Color fundus photograph. 45-degree field of view — 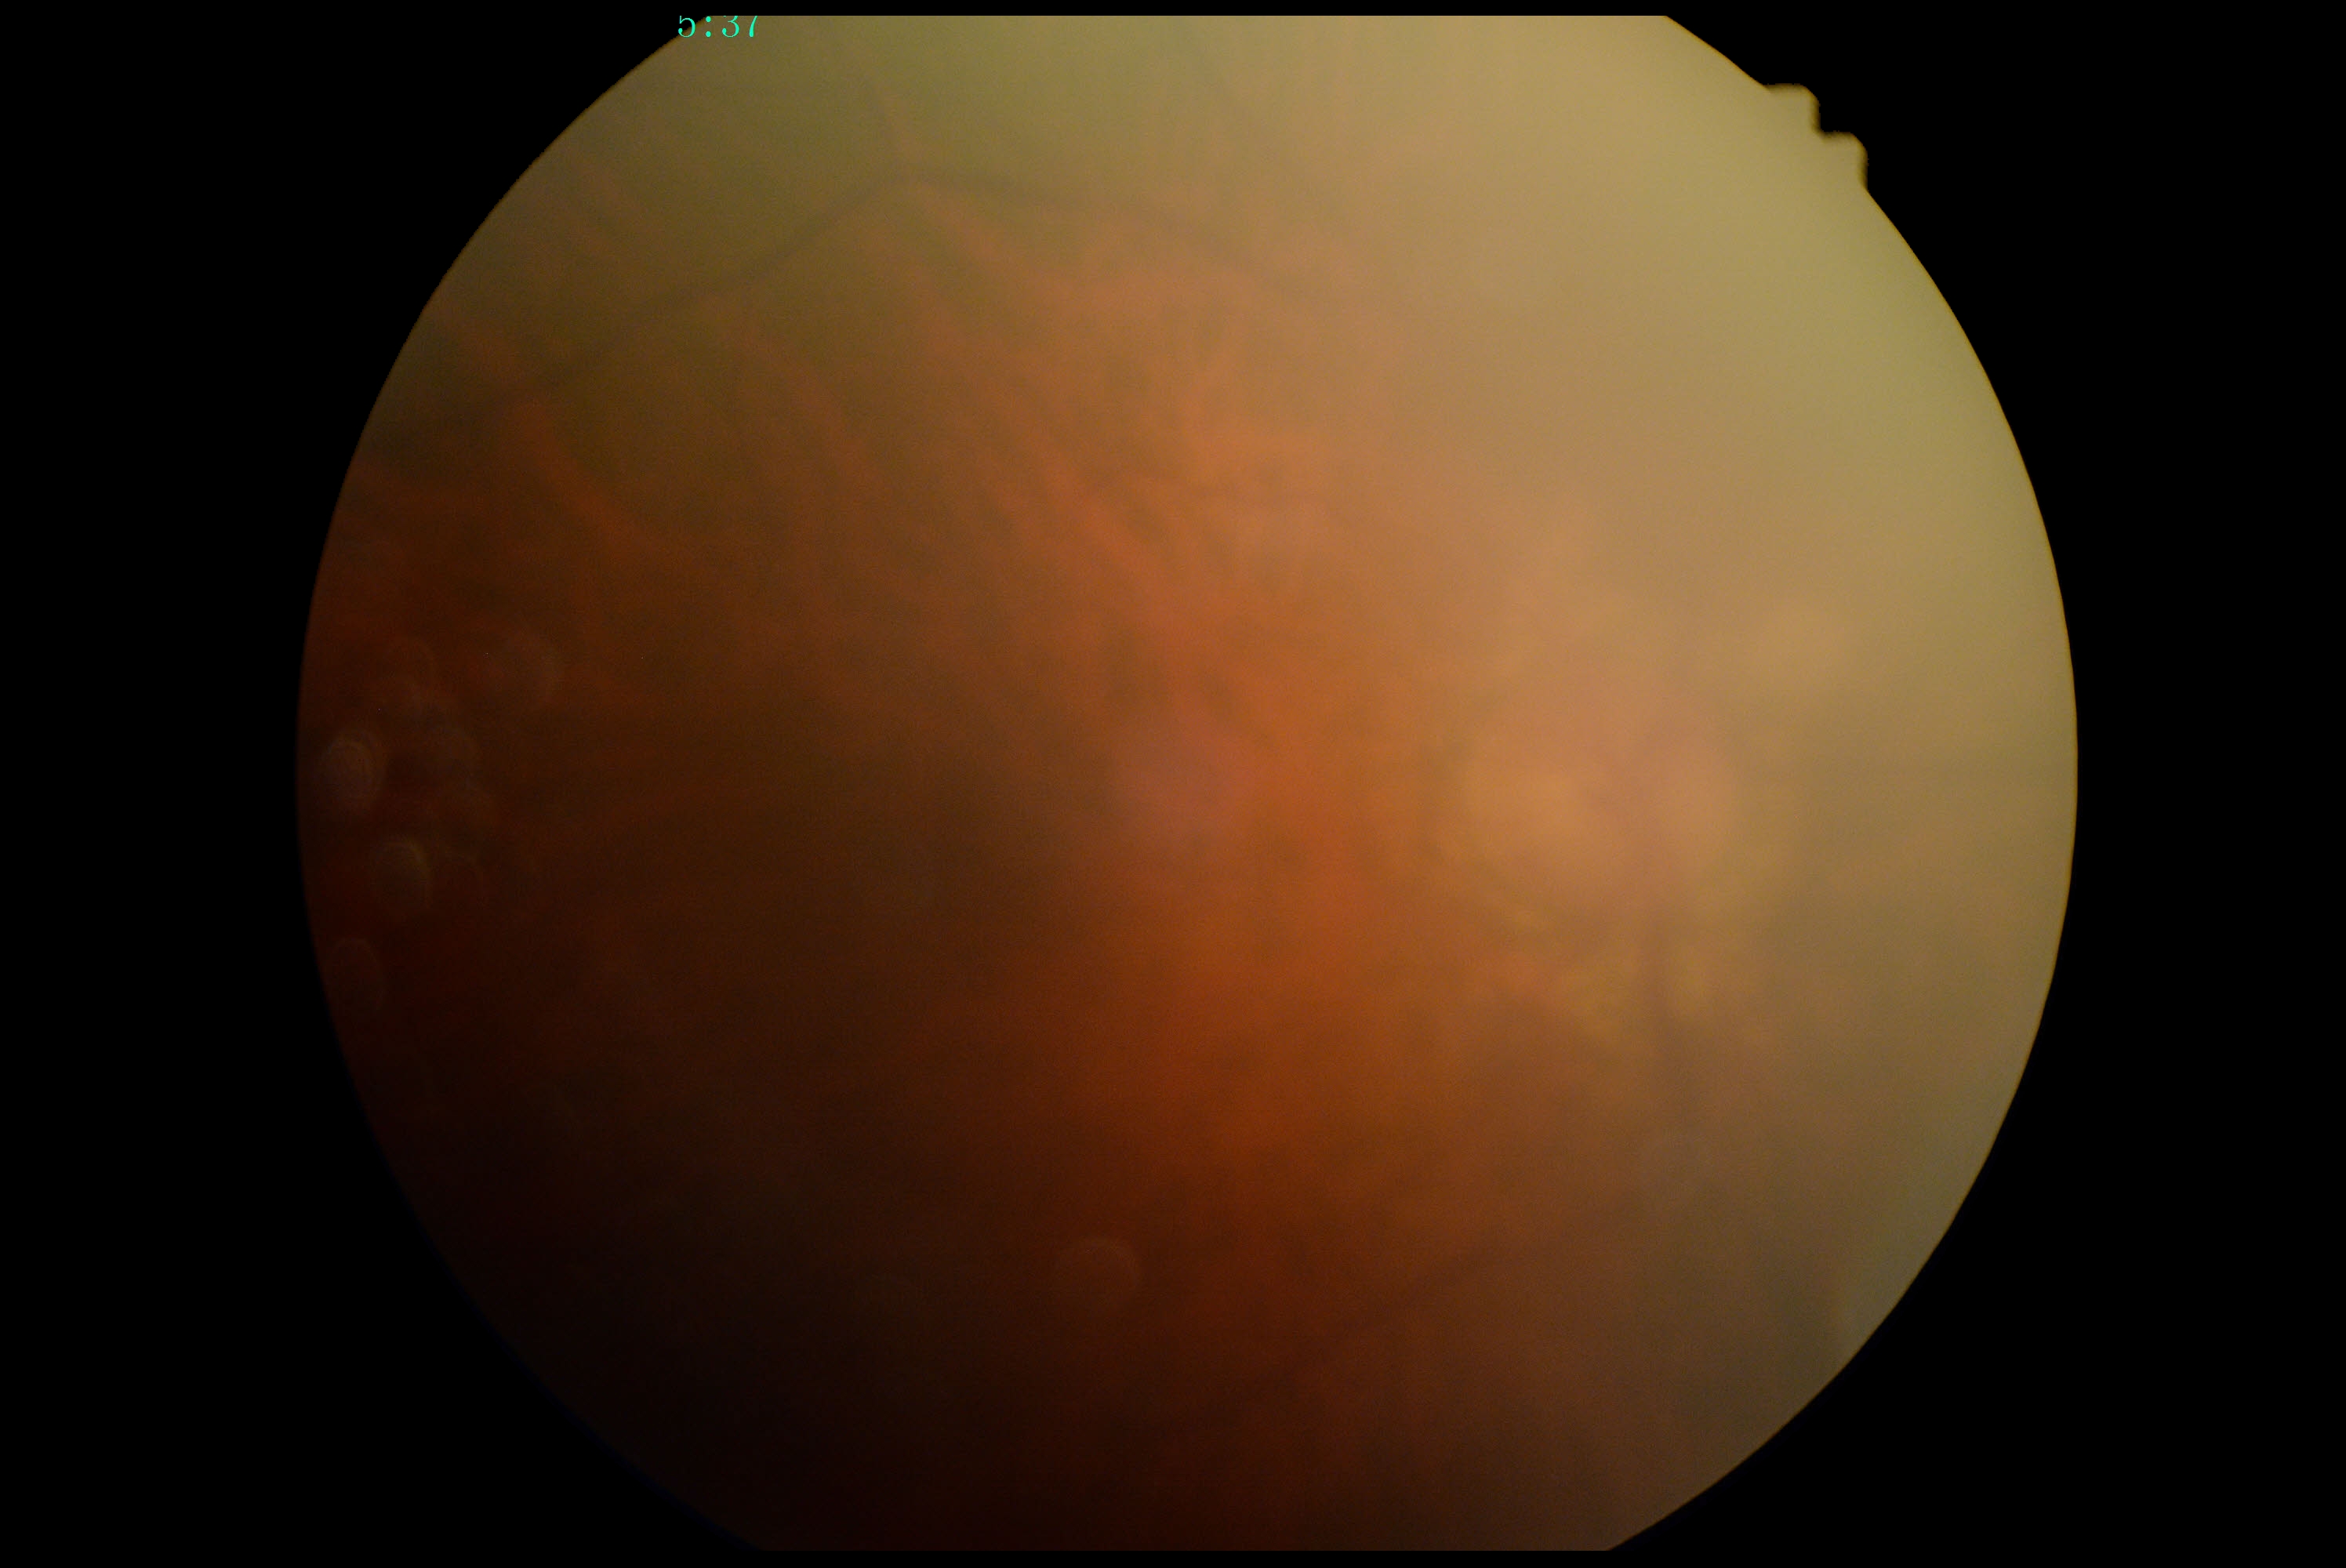   dr_grade: no apparent diabetic retinopathy (grade 0)